1932x1932 · 50° FOV · macula-centered — 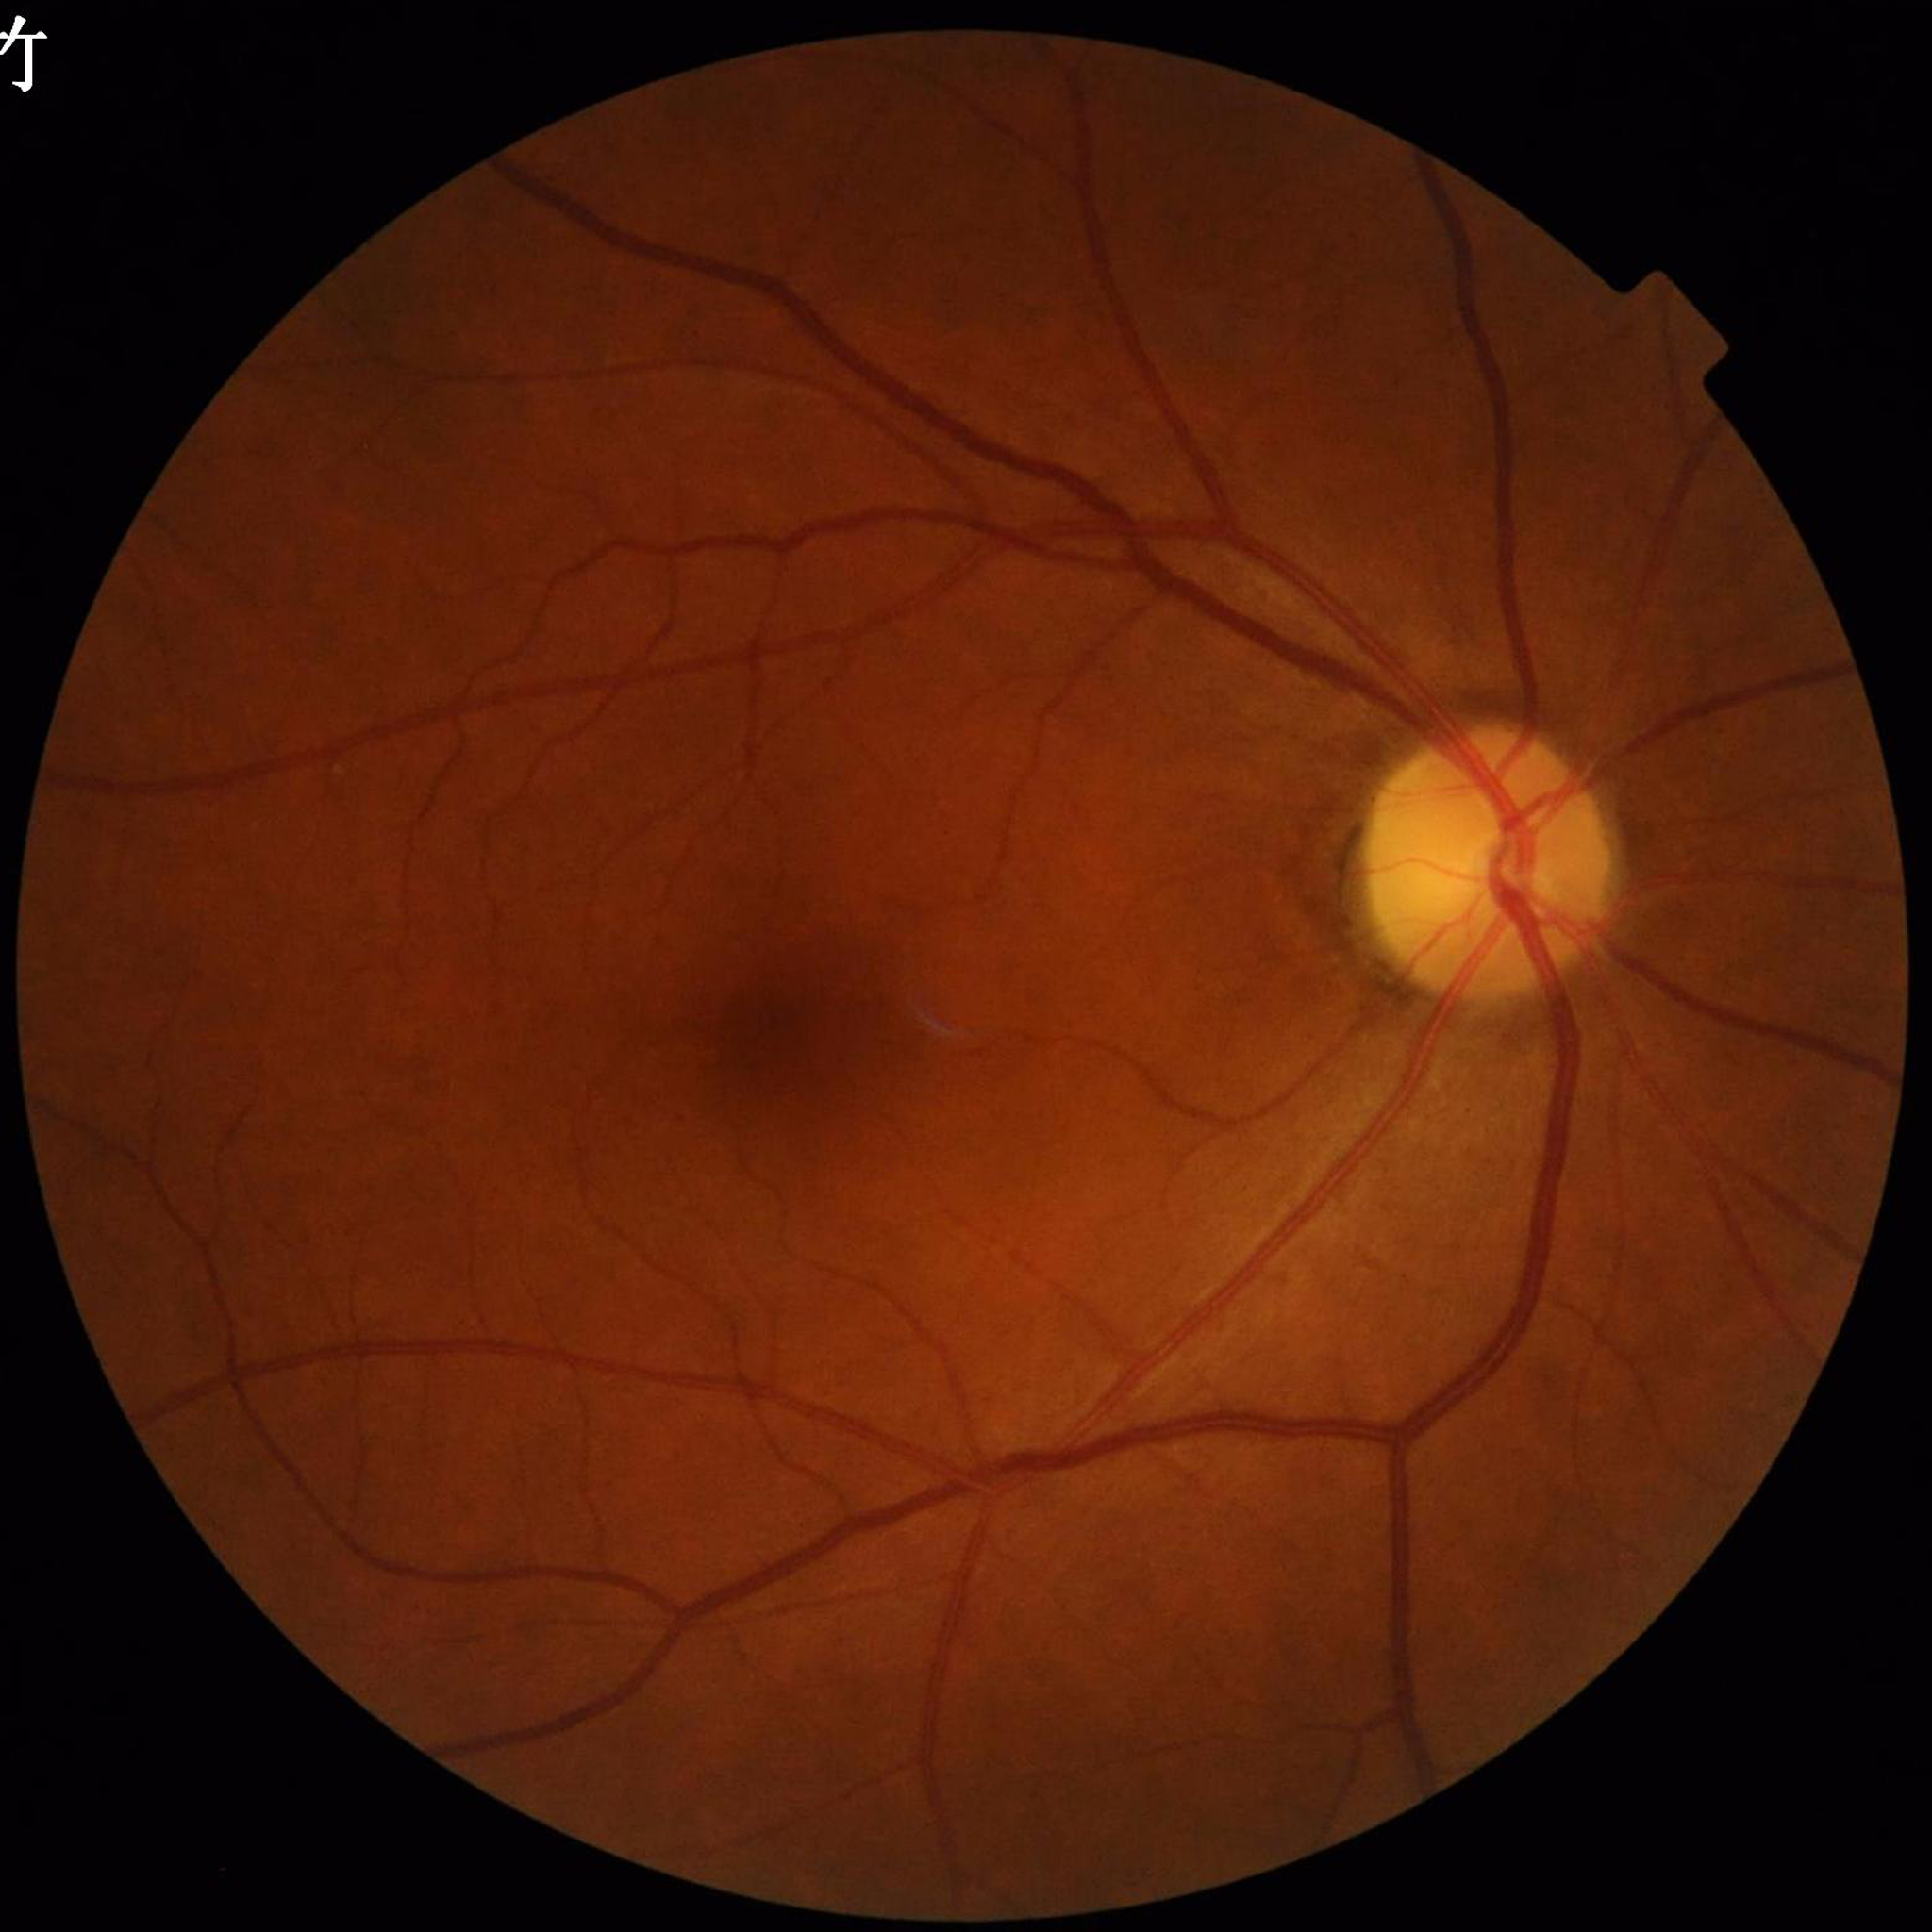
Condition: DR
Quality assessment: good